1240x1240px. Wide-field contact fundus photograph of an infant:
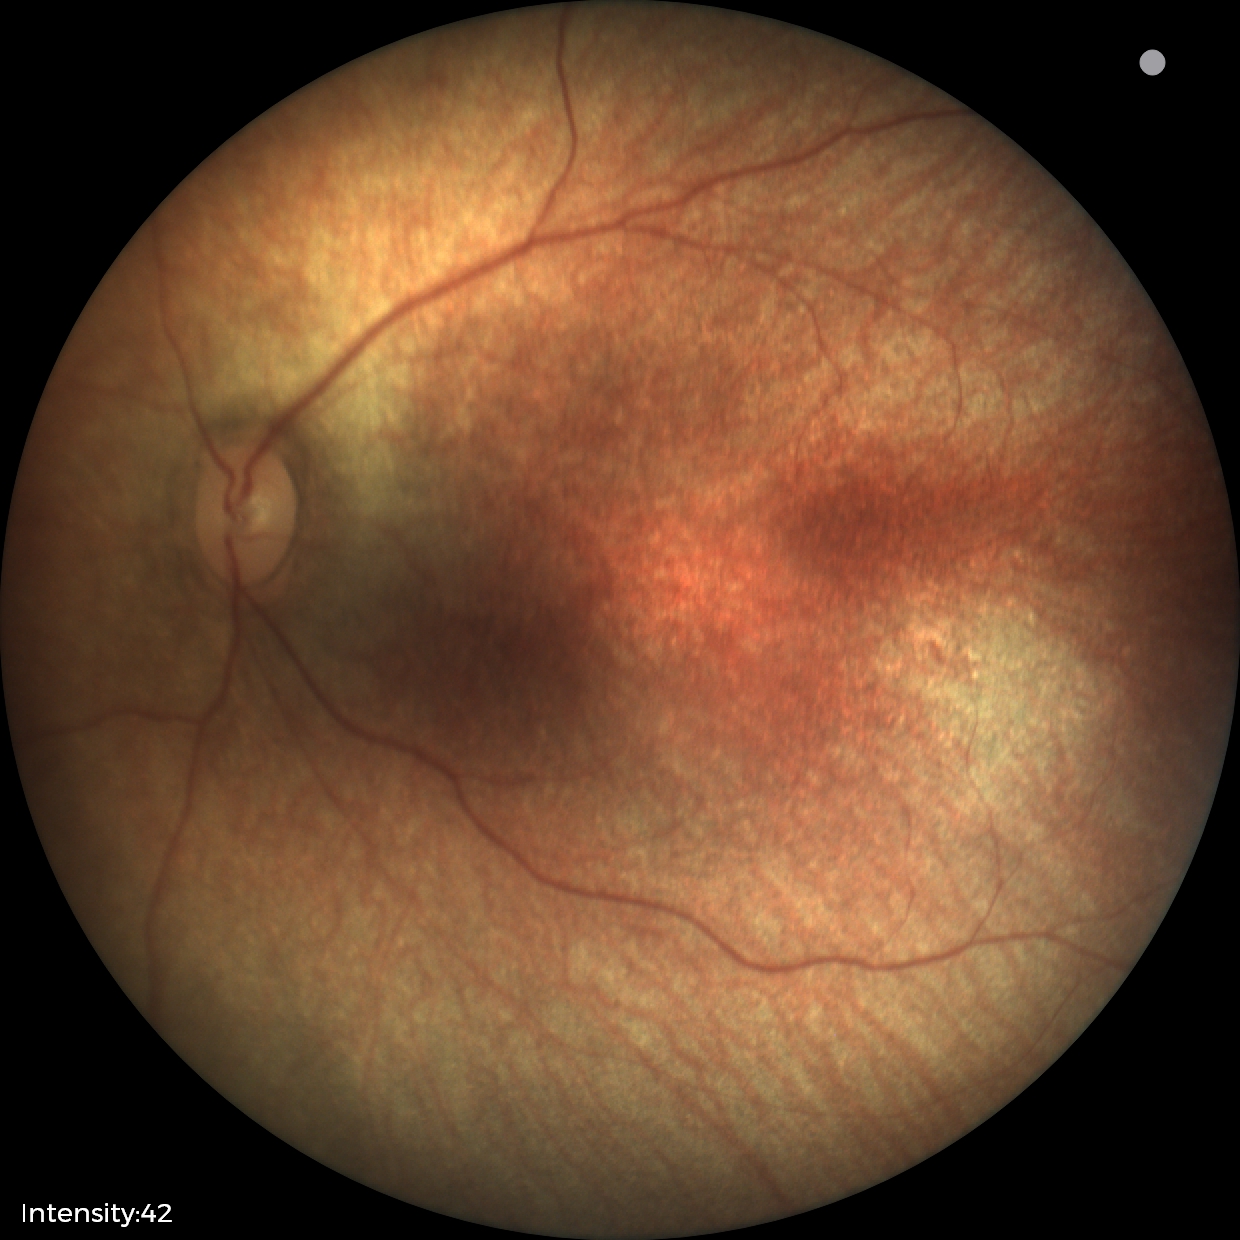
Finding = normal retinal appearance.